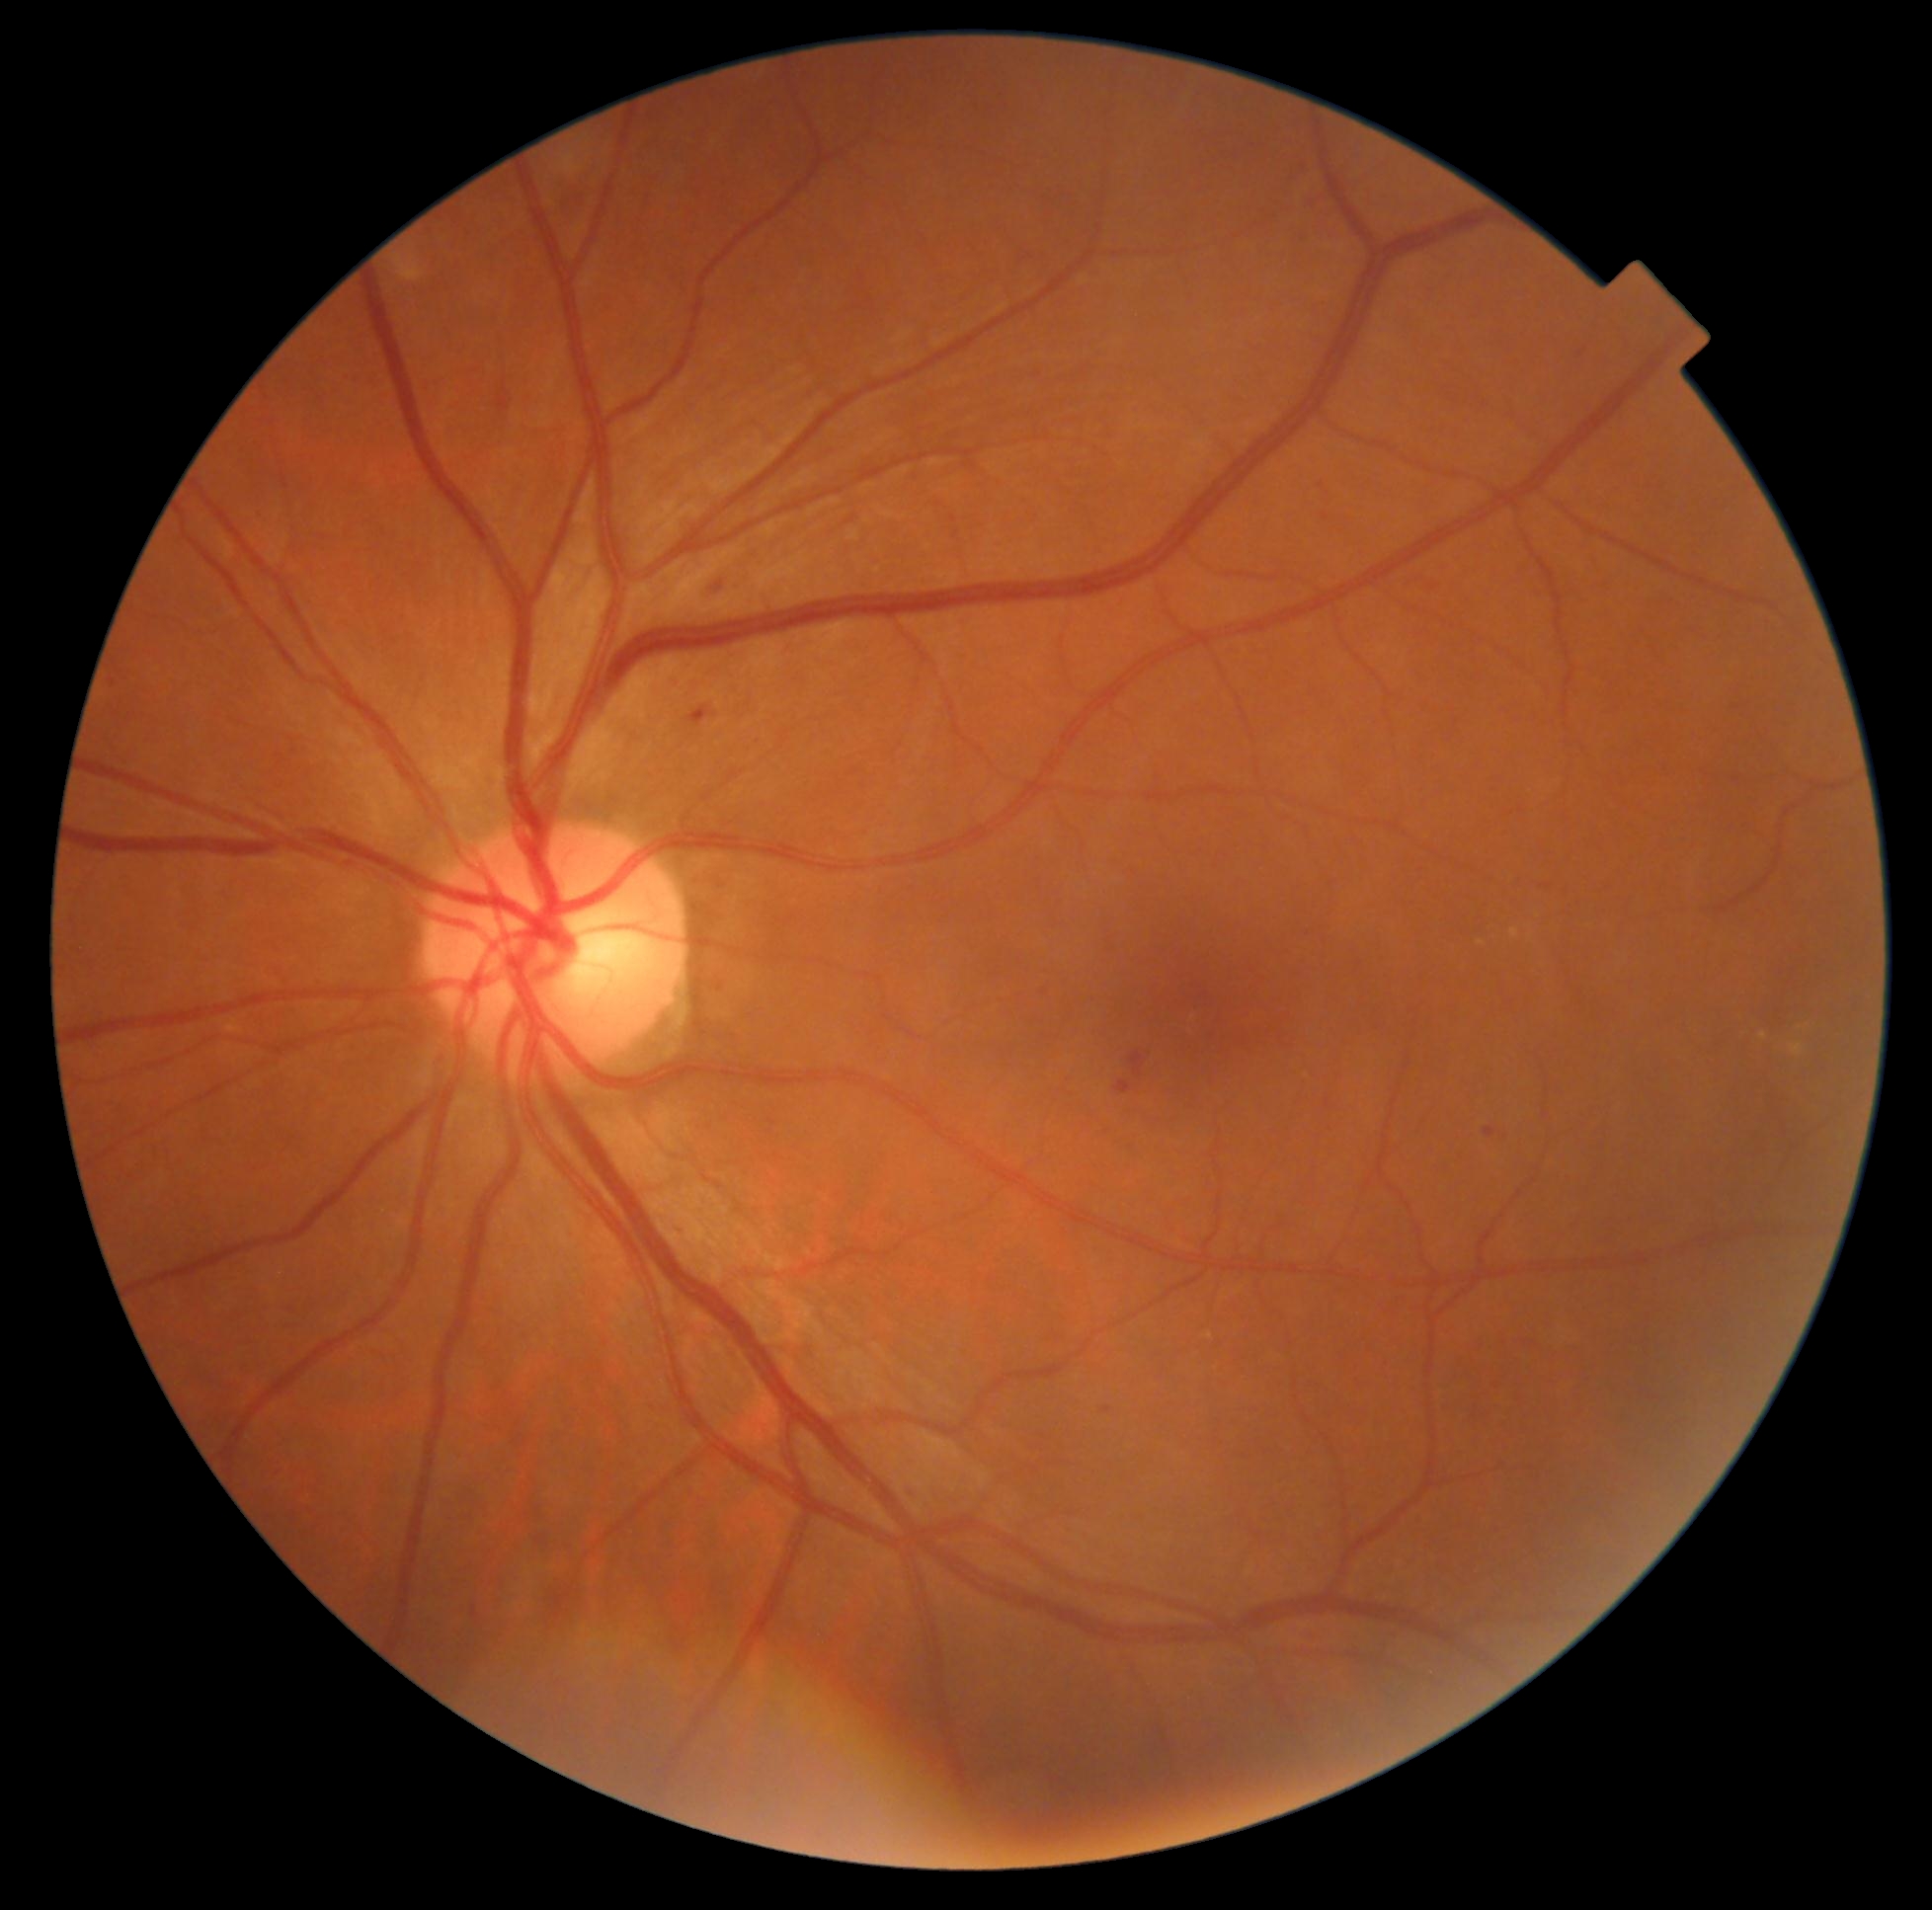
The retinopathy is classified as non-proliferative diabetic retinopathy.
DR severity is 2 — more than just microaneurysms but less than severe NPDR.